Remidio FOP fundus camera · fundus photo
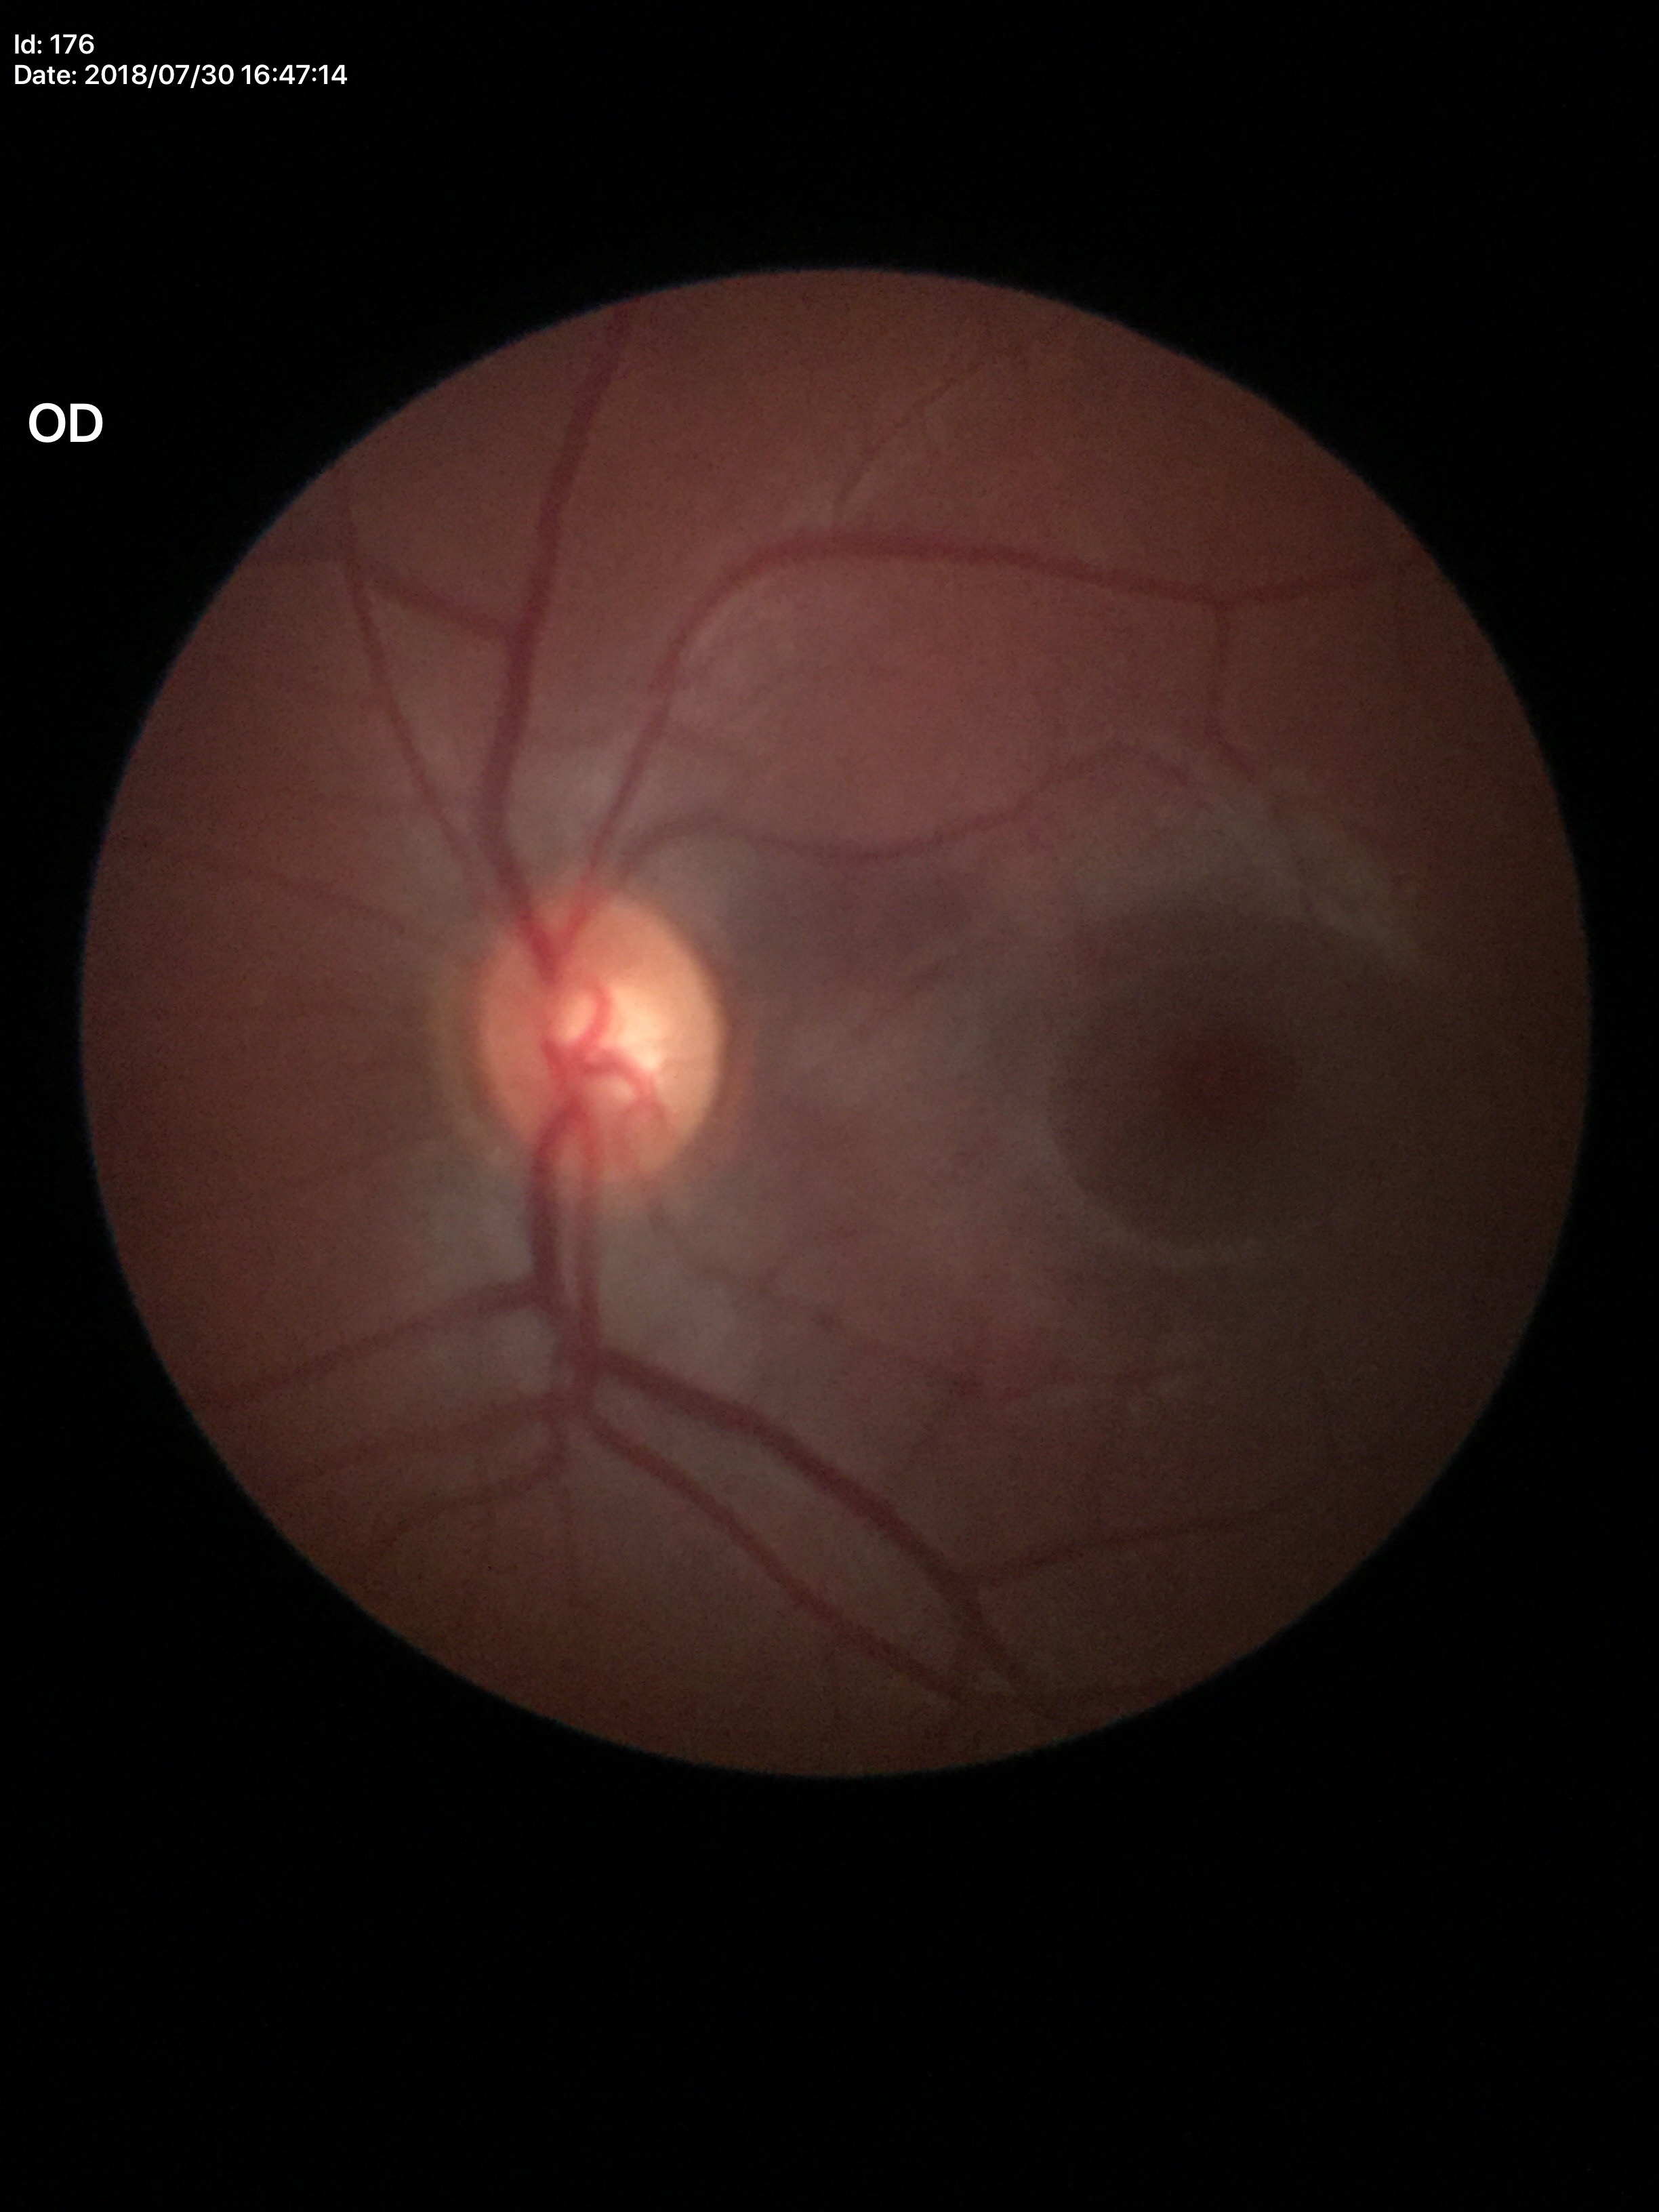

Glaucoma evaluation: no suspicious findings (1/5 graders called glaucoma suspect) | vertical C/D ratio: 0.55 | horizontal C/D ratio: 0.55